Image size 1920x1440: 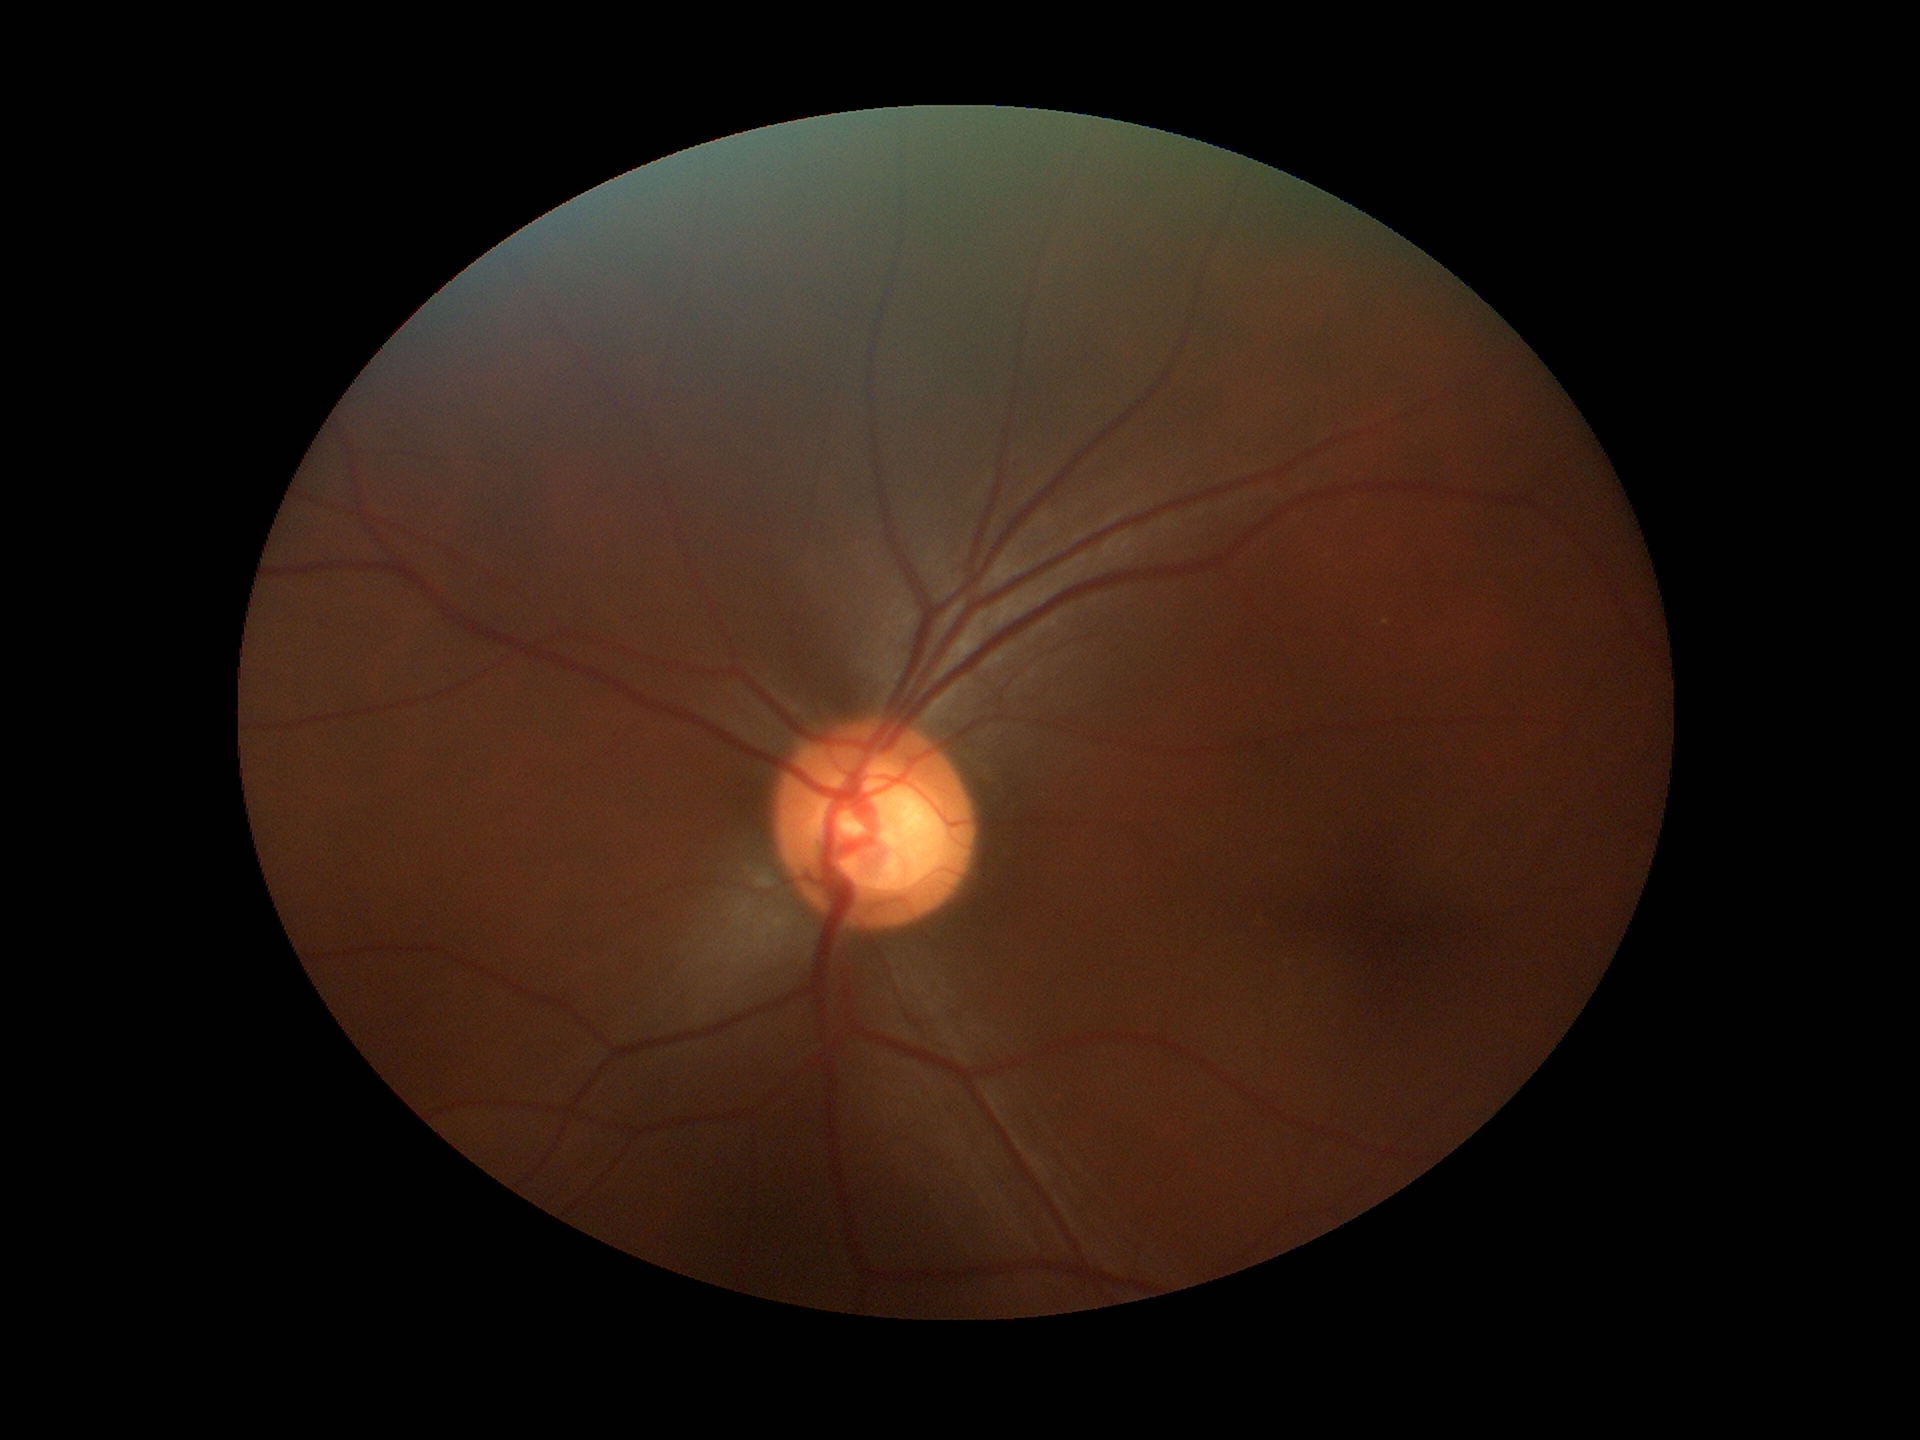
Glaucoma screening impression: suspect.
Horizontal CDR (HCDR) is 0.69.
Vertical cup-disc ratio (VCDR): 0.63.